45° FOV, 2352 x 1568 pixels, CFP
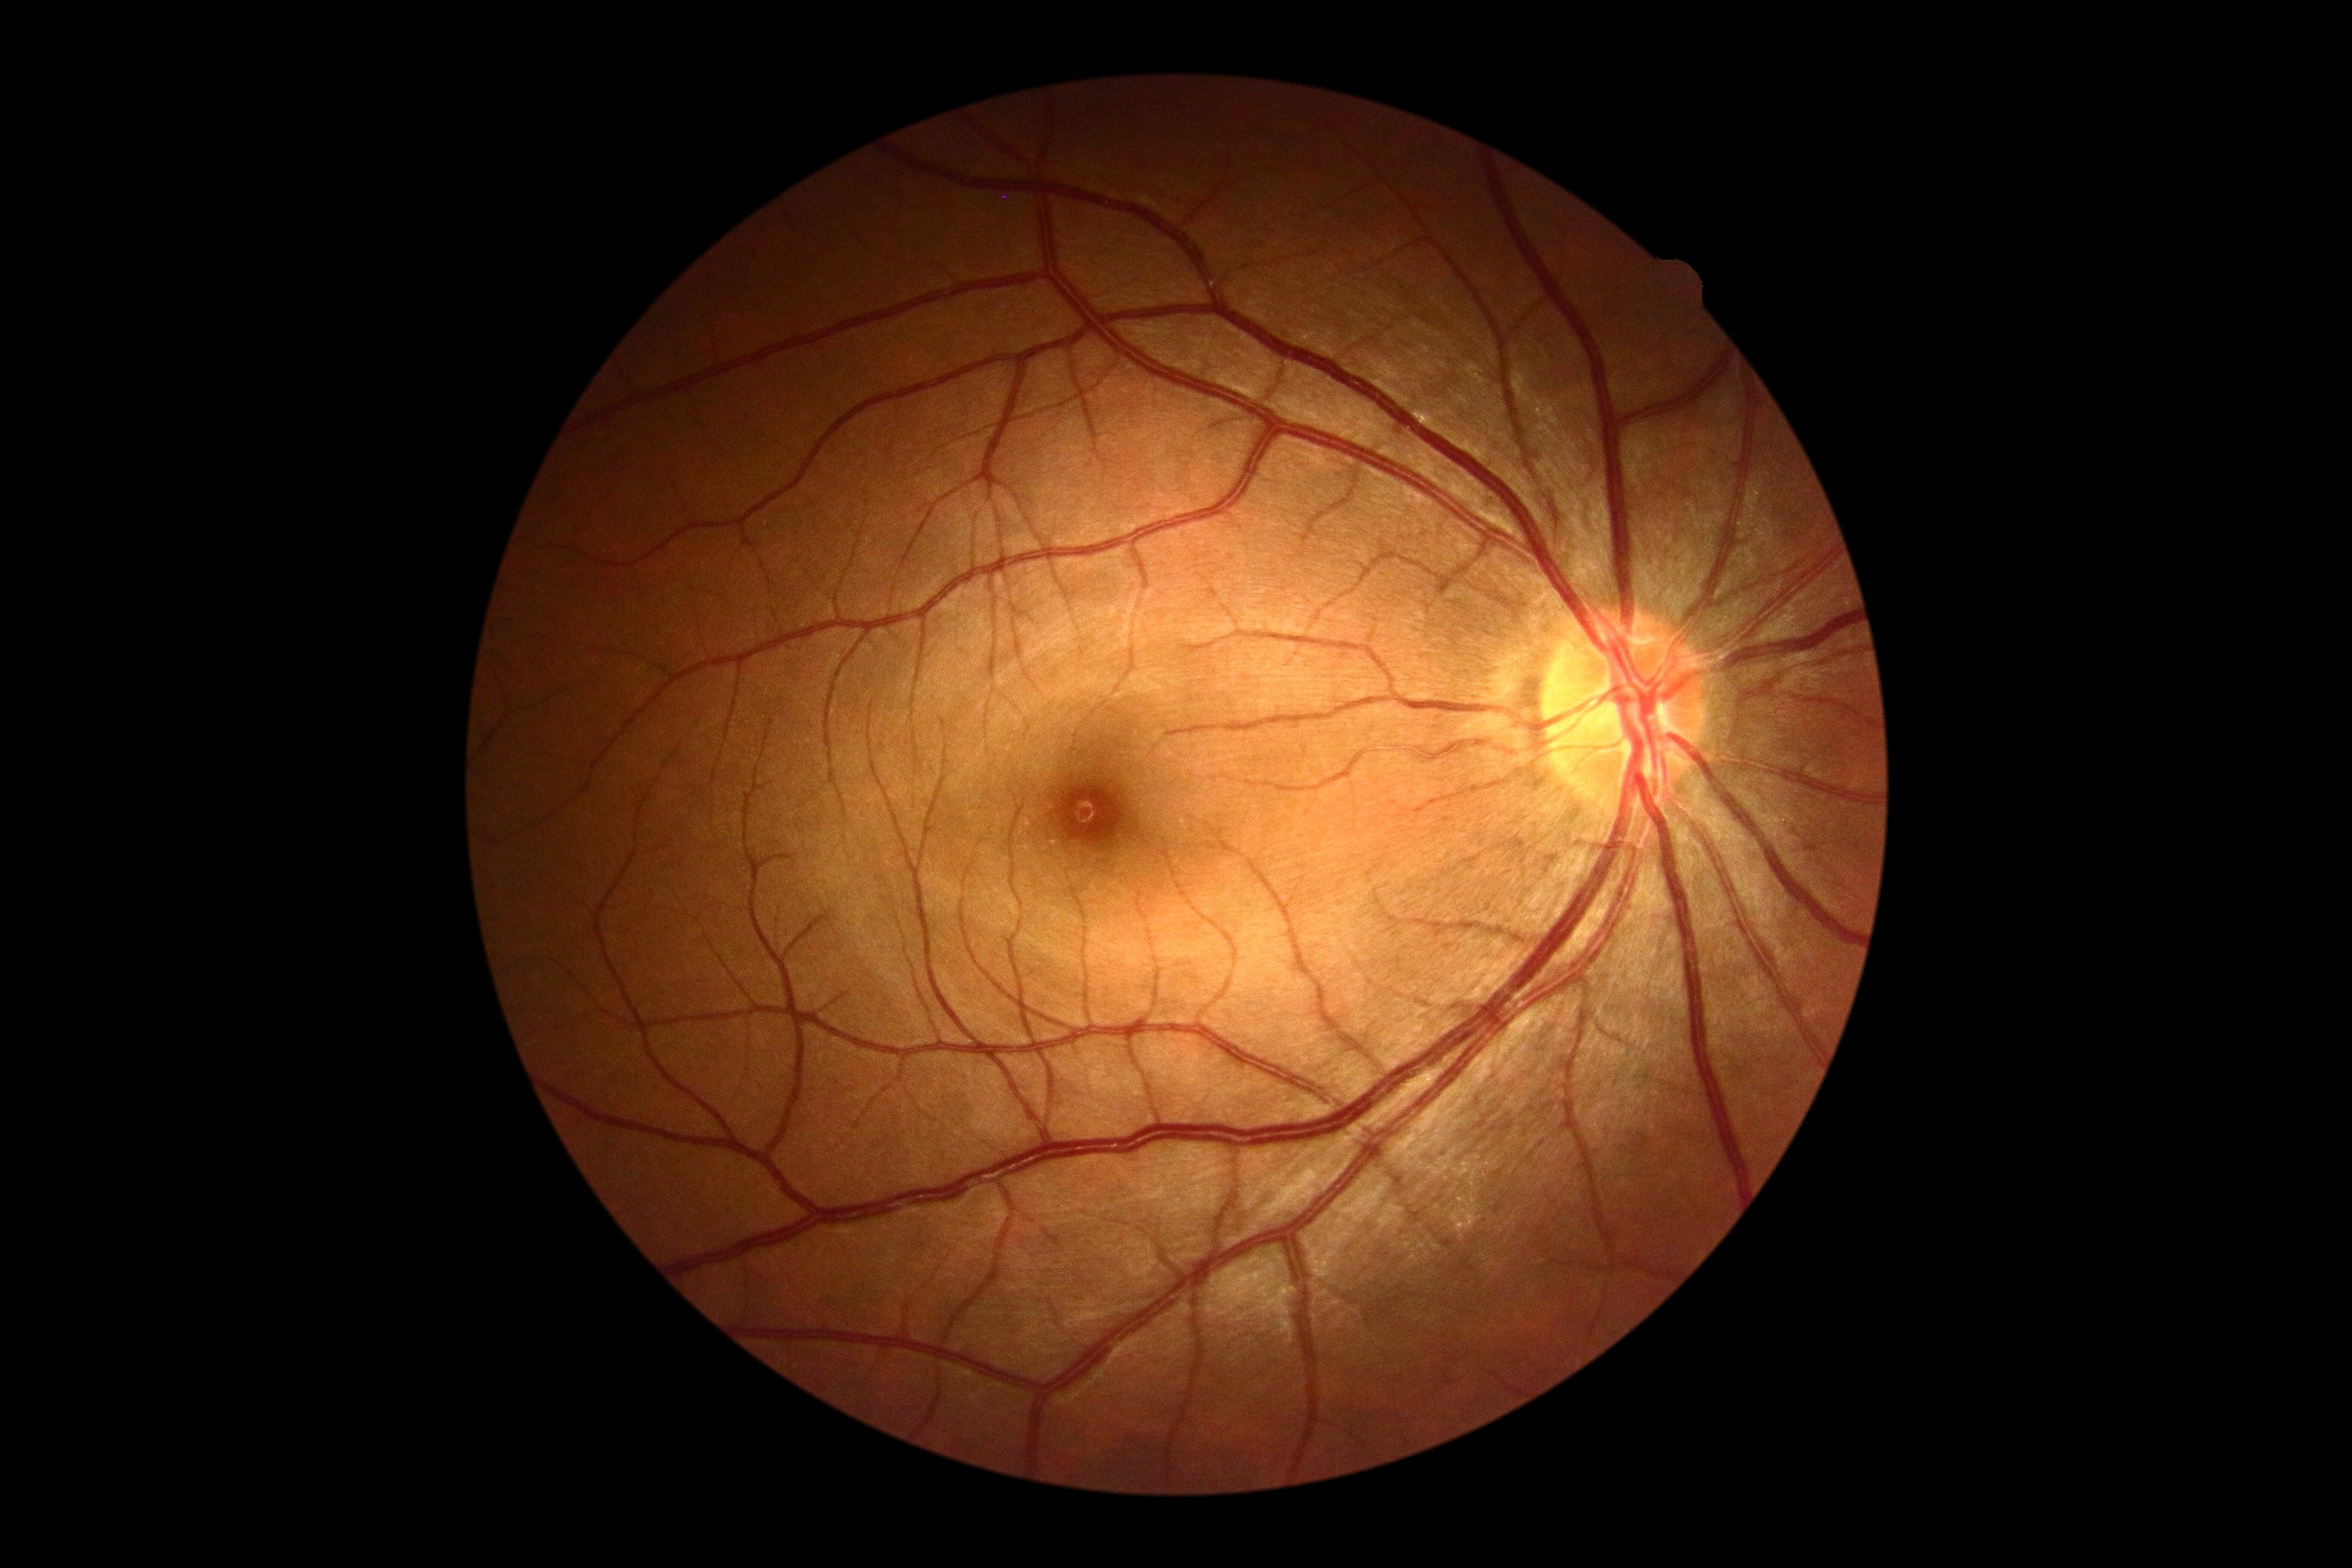 Annotations:
* DR stage — no apparent retinopathy (grade 0)